Wide-field fundus photograph of an infant.
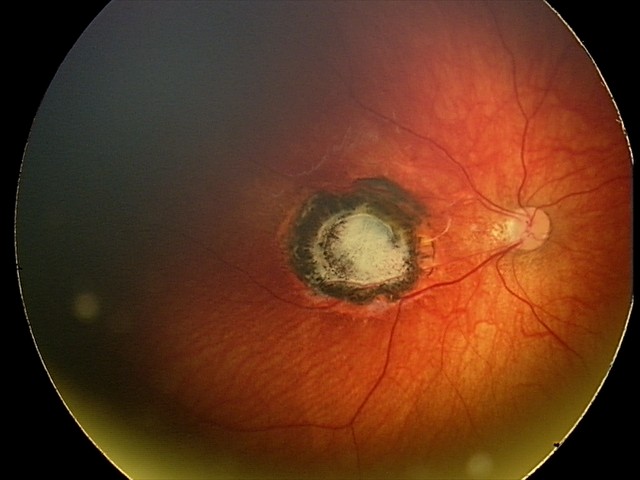
Series diagnosed as toxoplasmosis chorioretinitis.